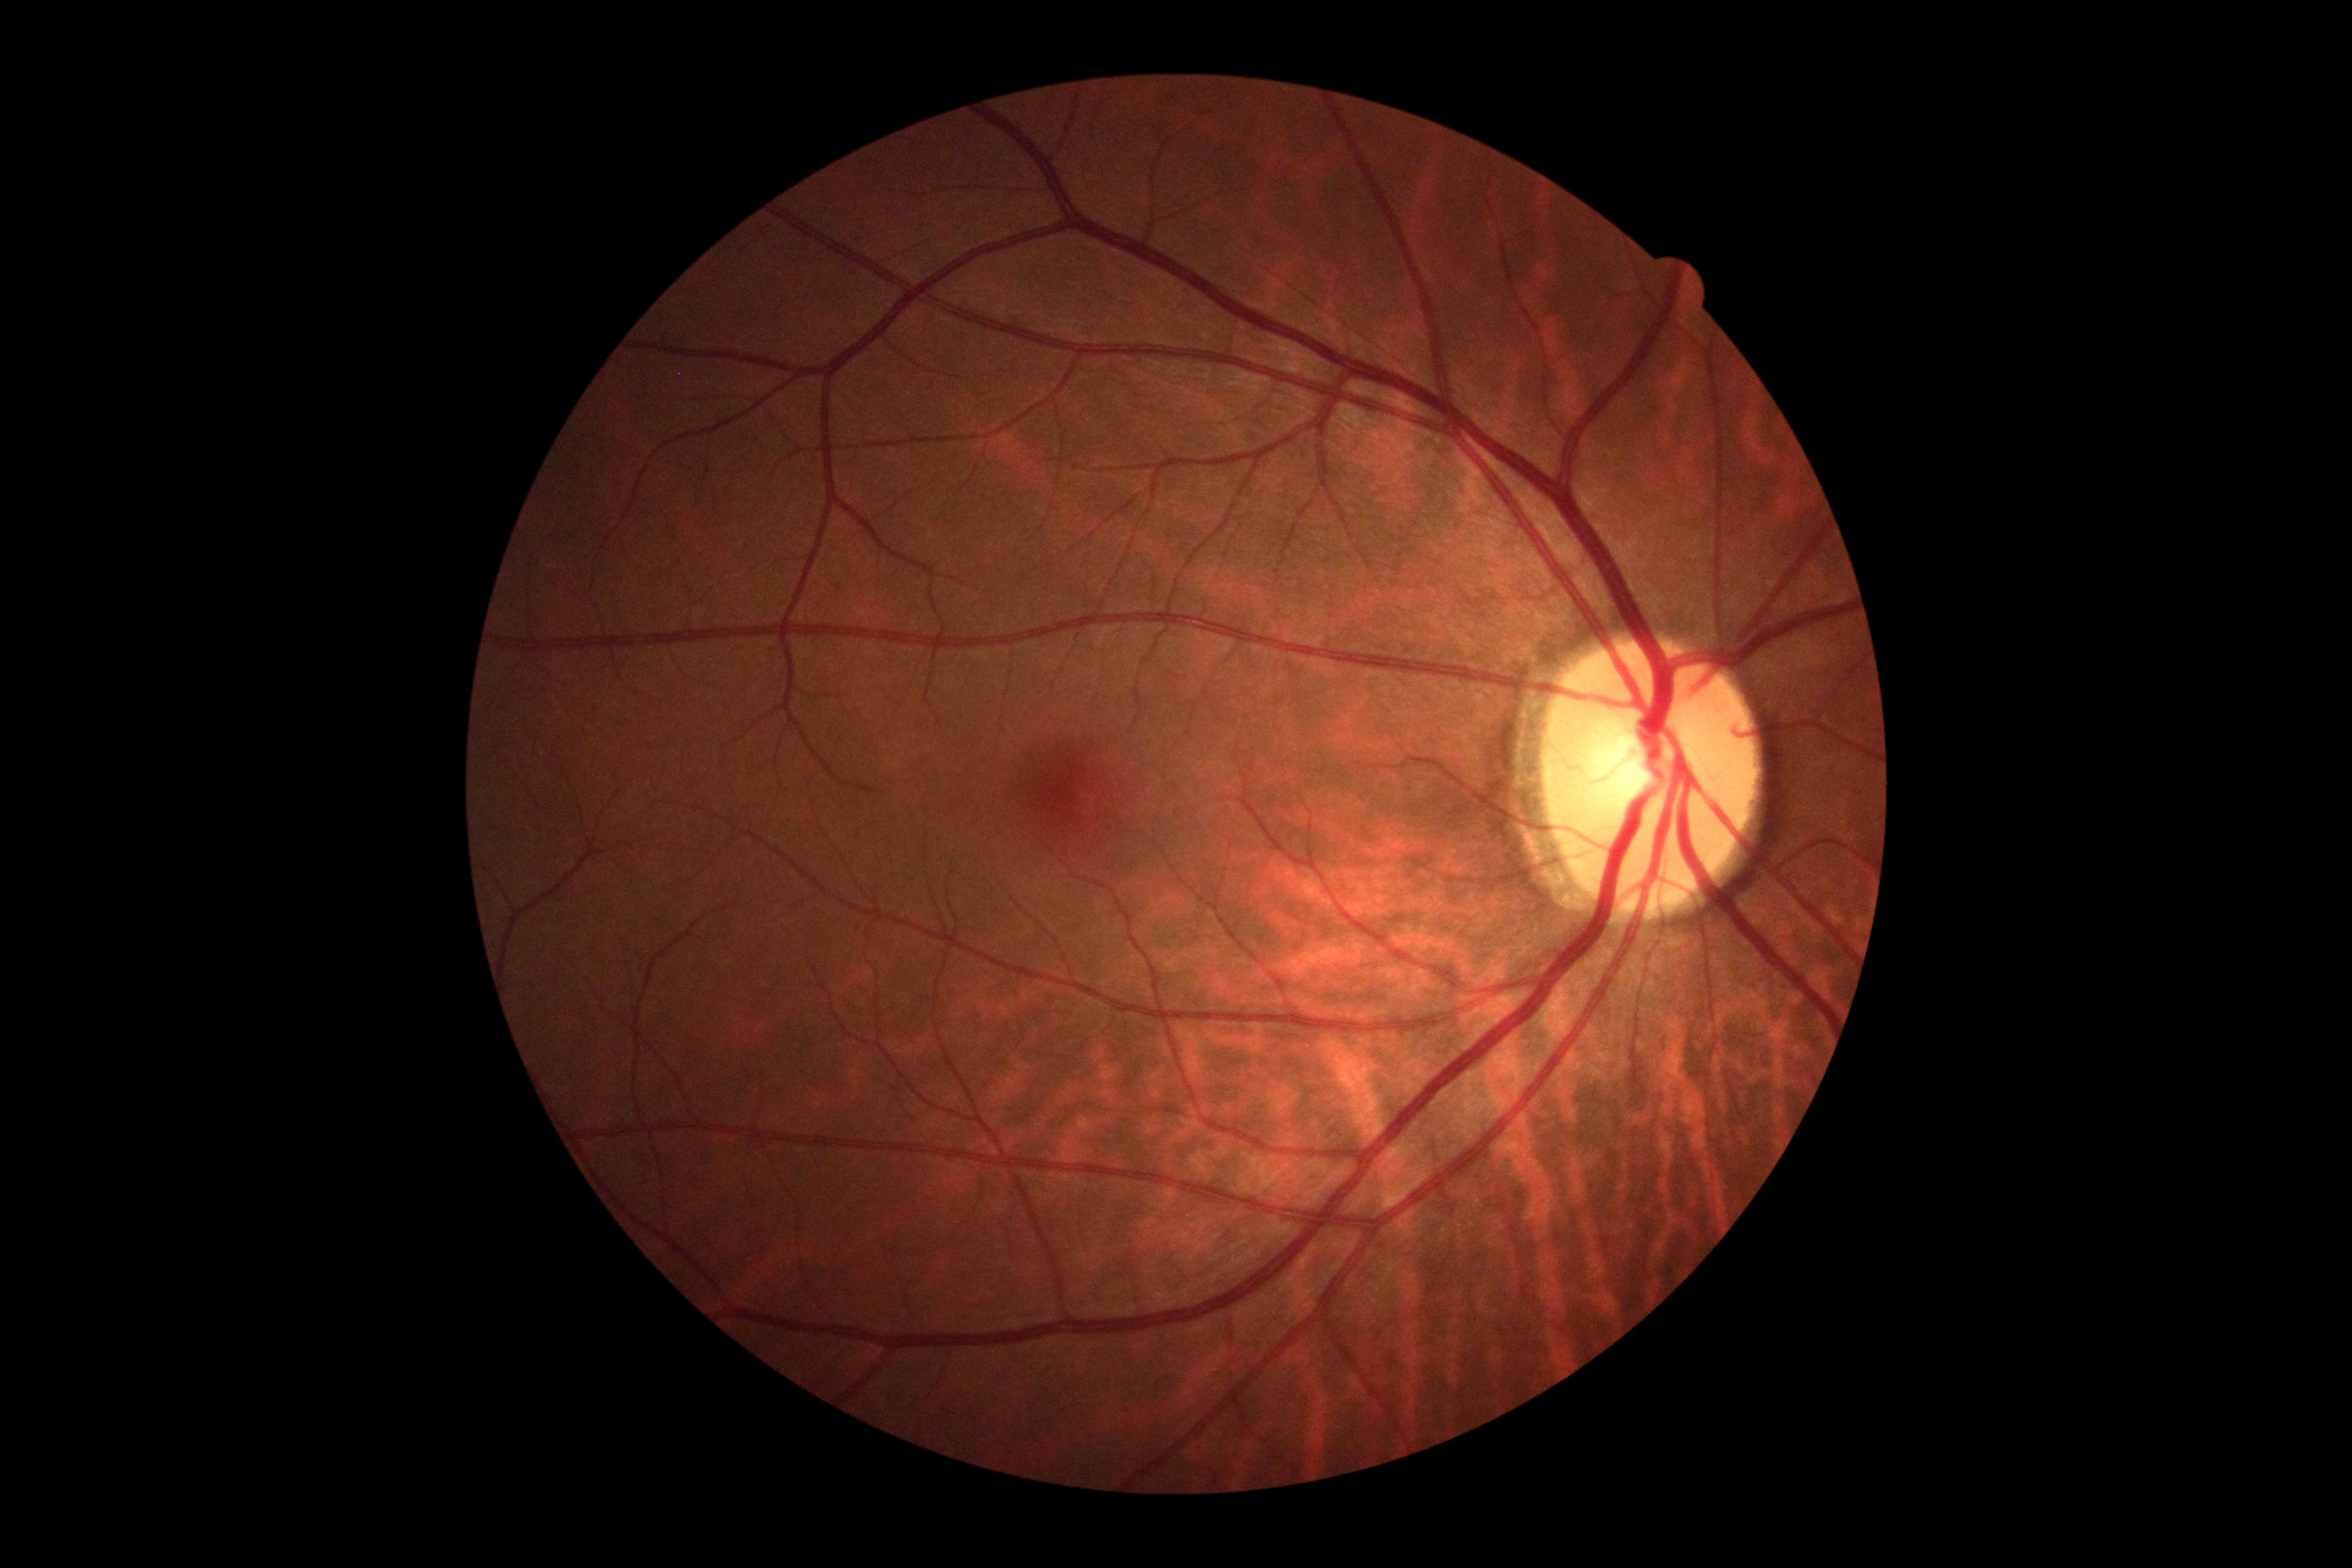
DR grade is 0. No DR findings.